Retinal fundus photograph: 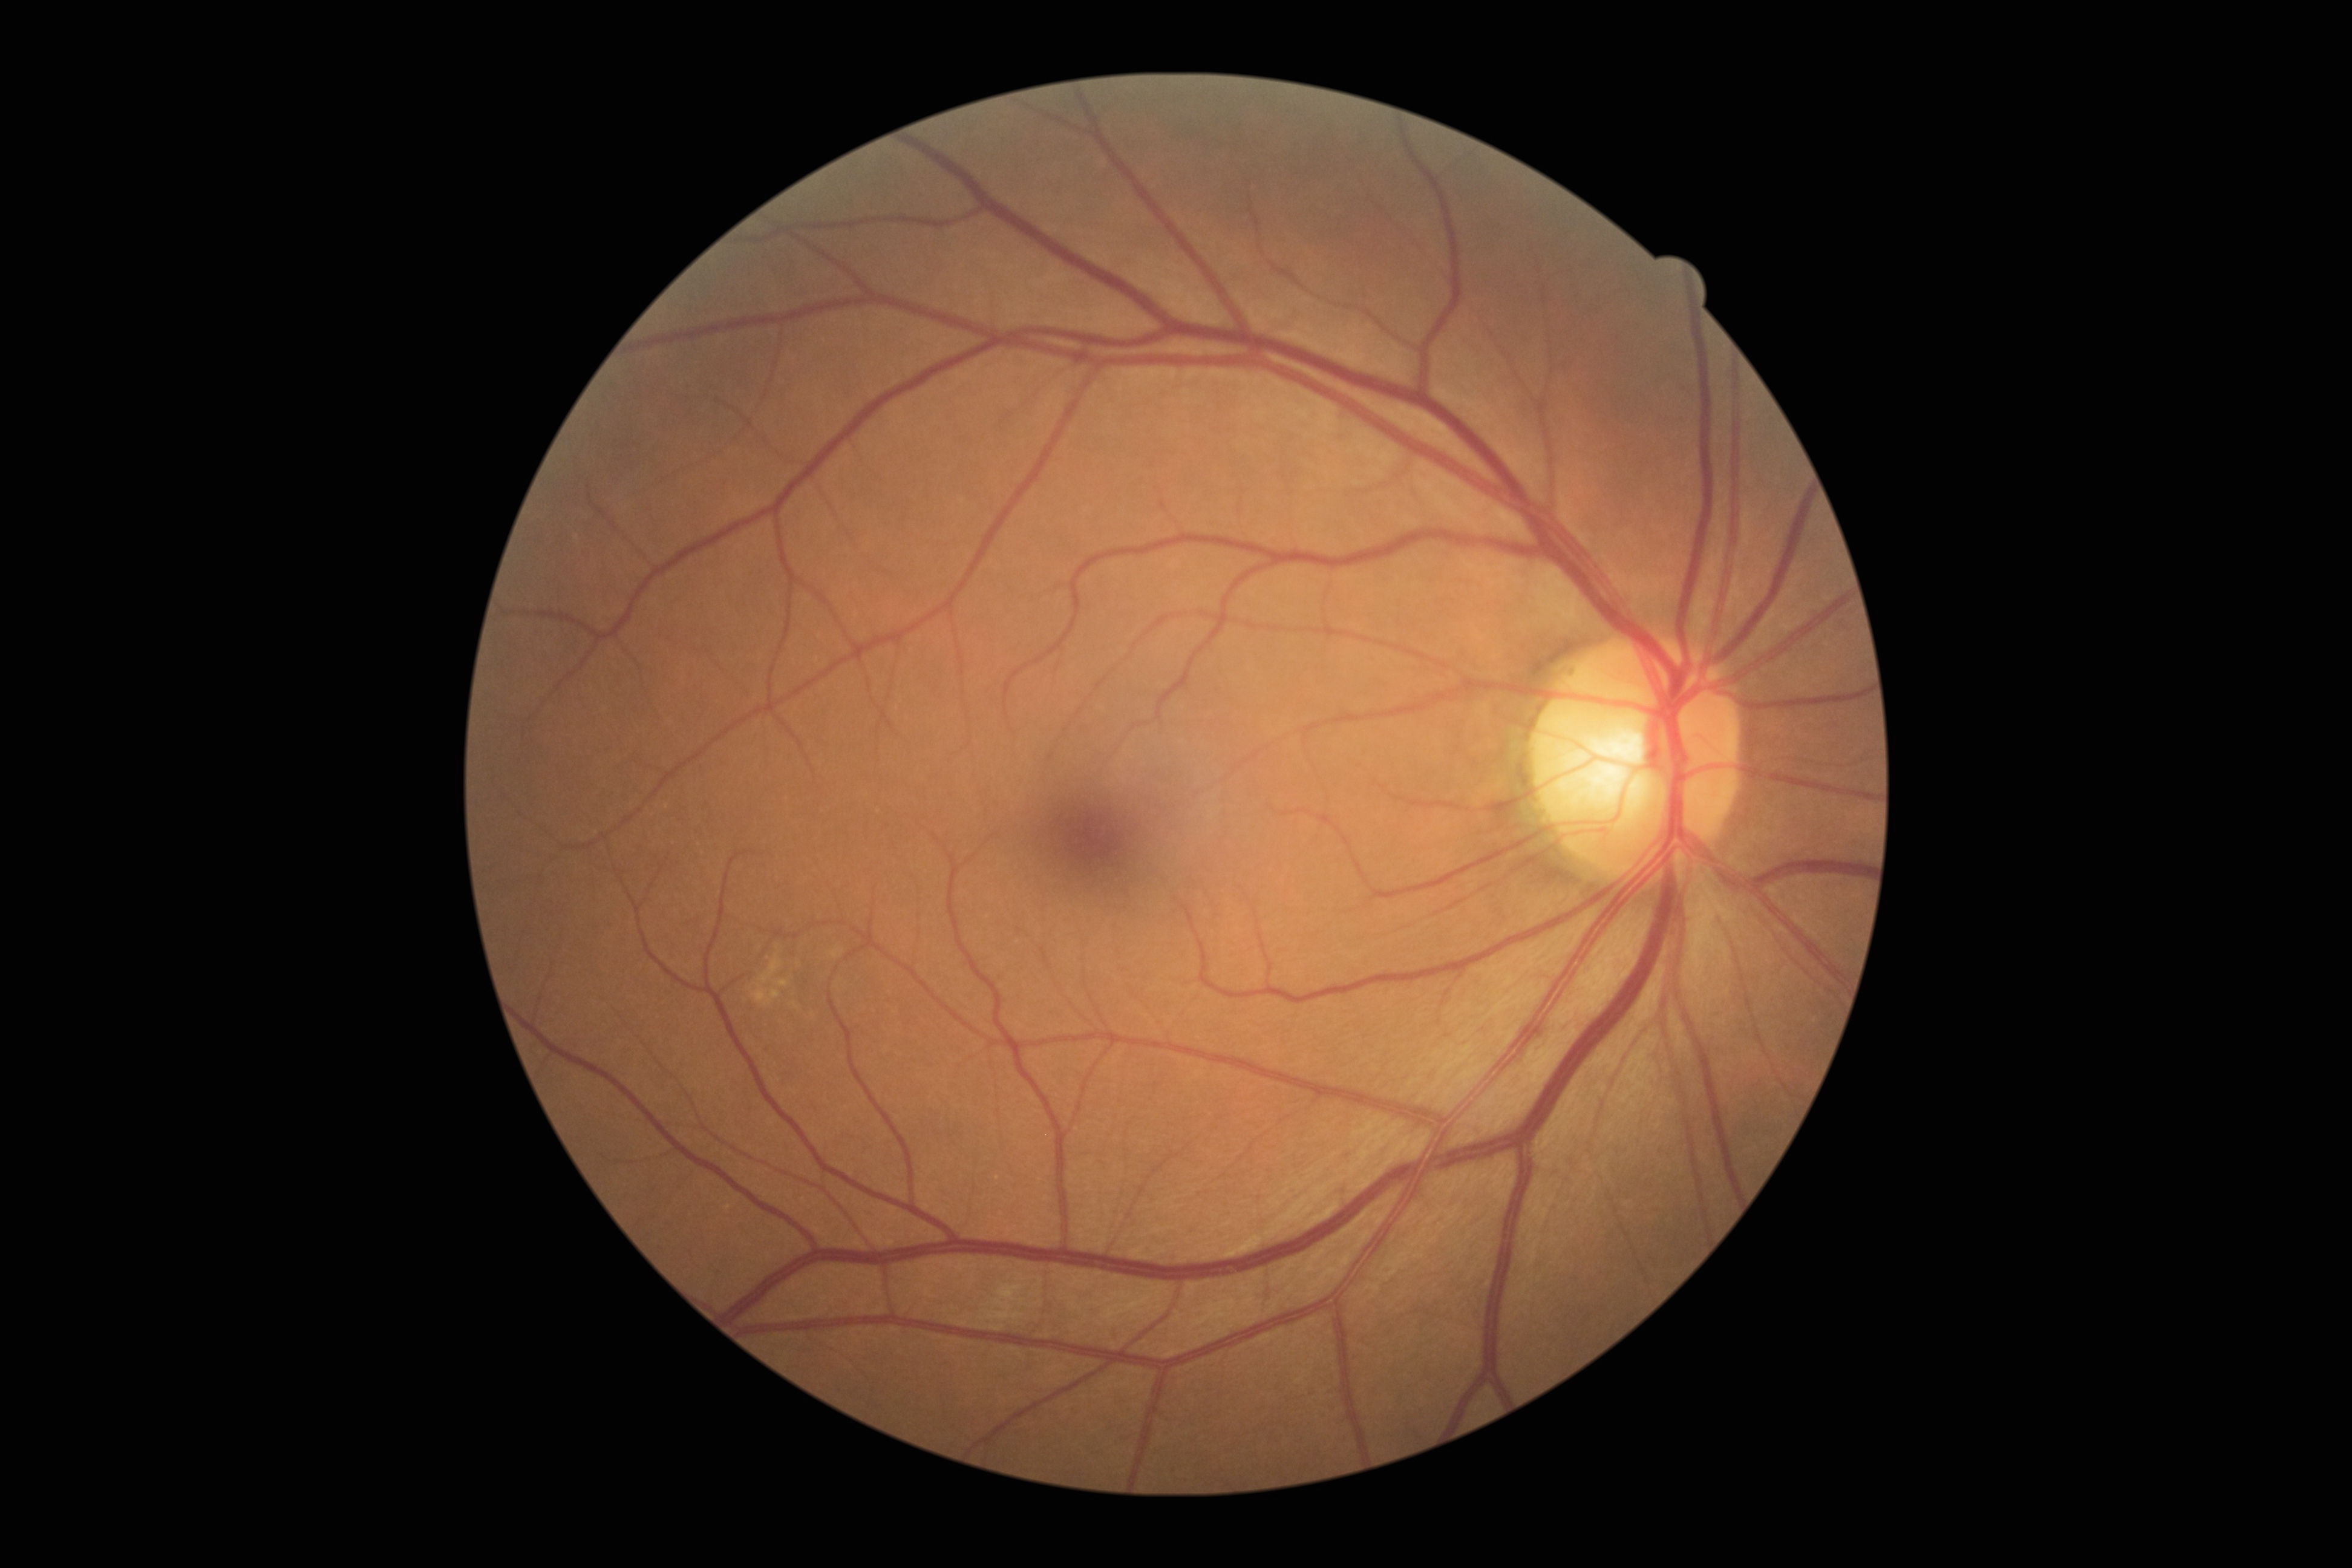
retinopathy grade: 2.